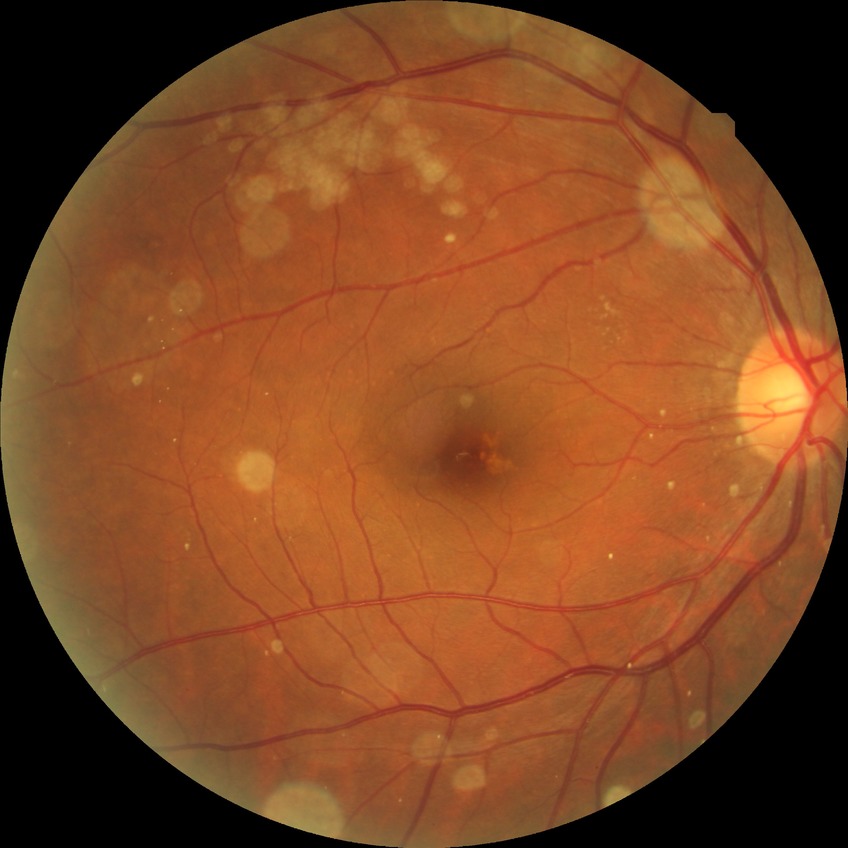

Diabetic retinopathy grade: no diabetic retinopathy.